Graded on the modified Davis scale, FOV: 45 degrees — 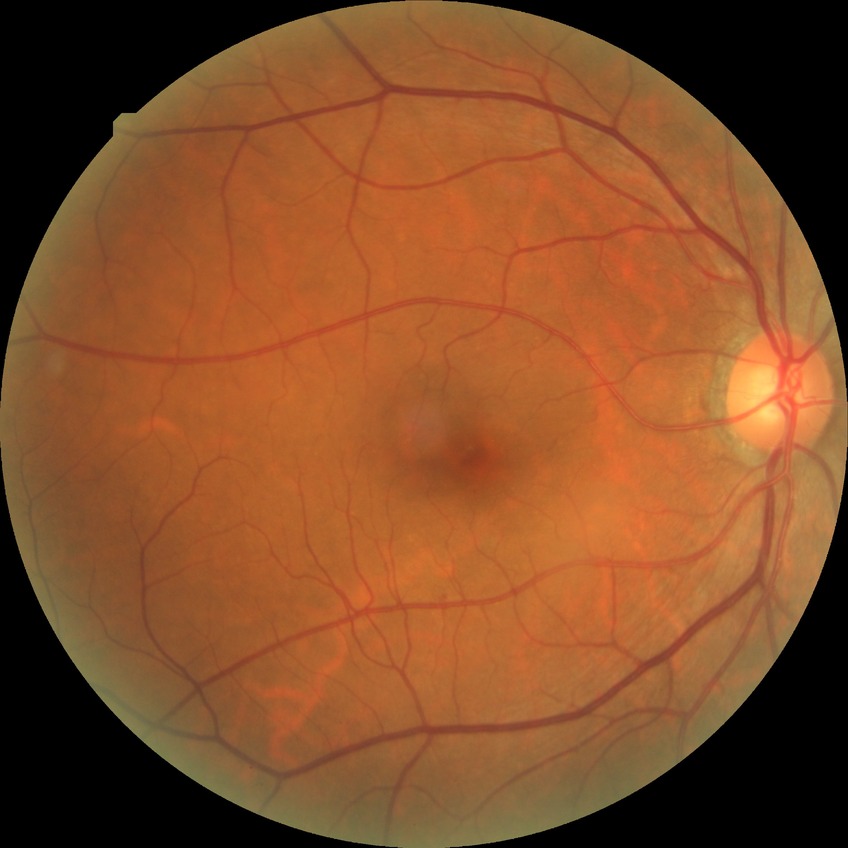

Findings:
– modified Davis grading — no diabetic retinopathy